2352 by 1568 pixels, 45-degree field of view, CFP:
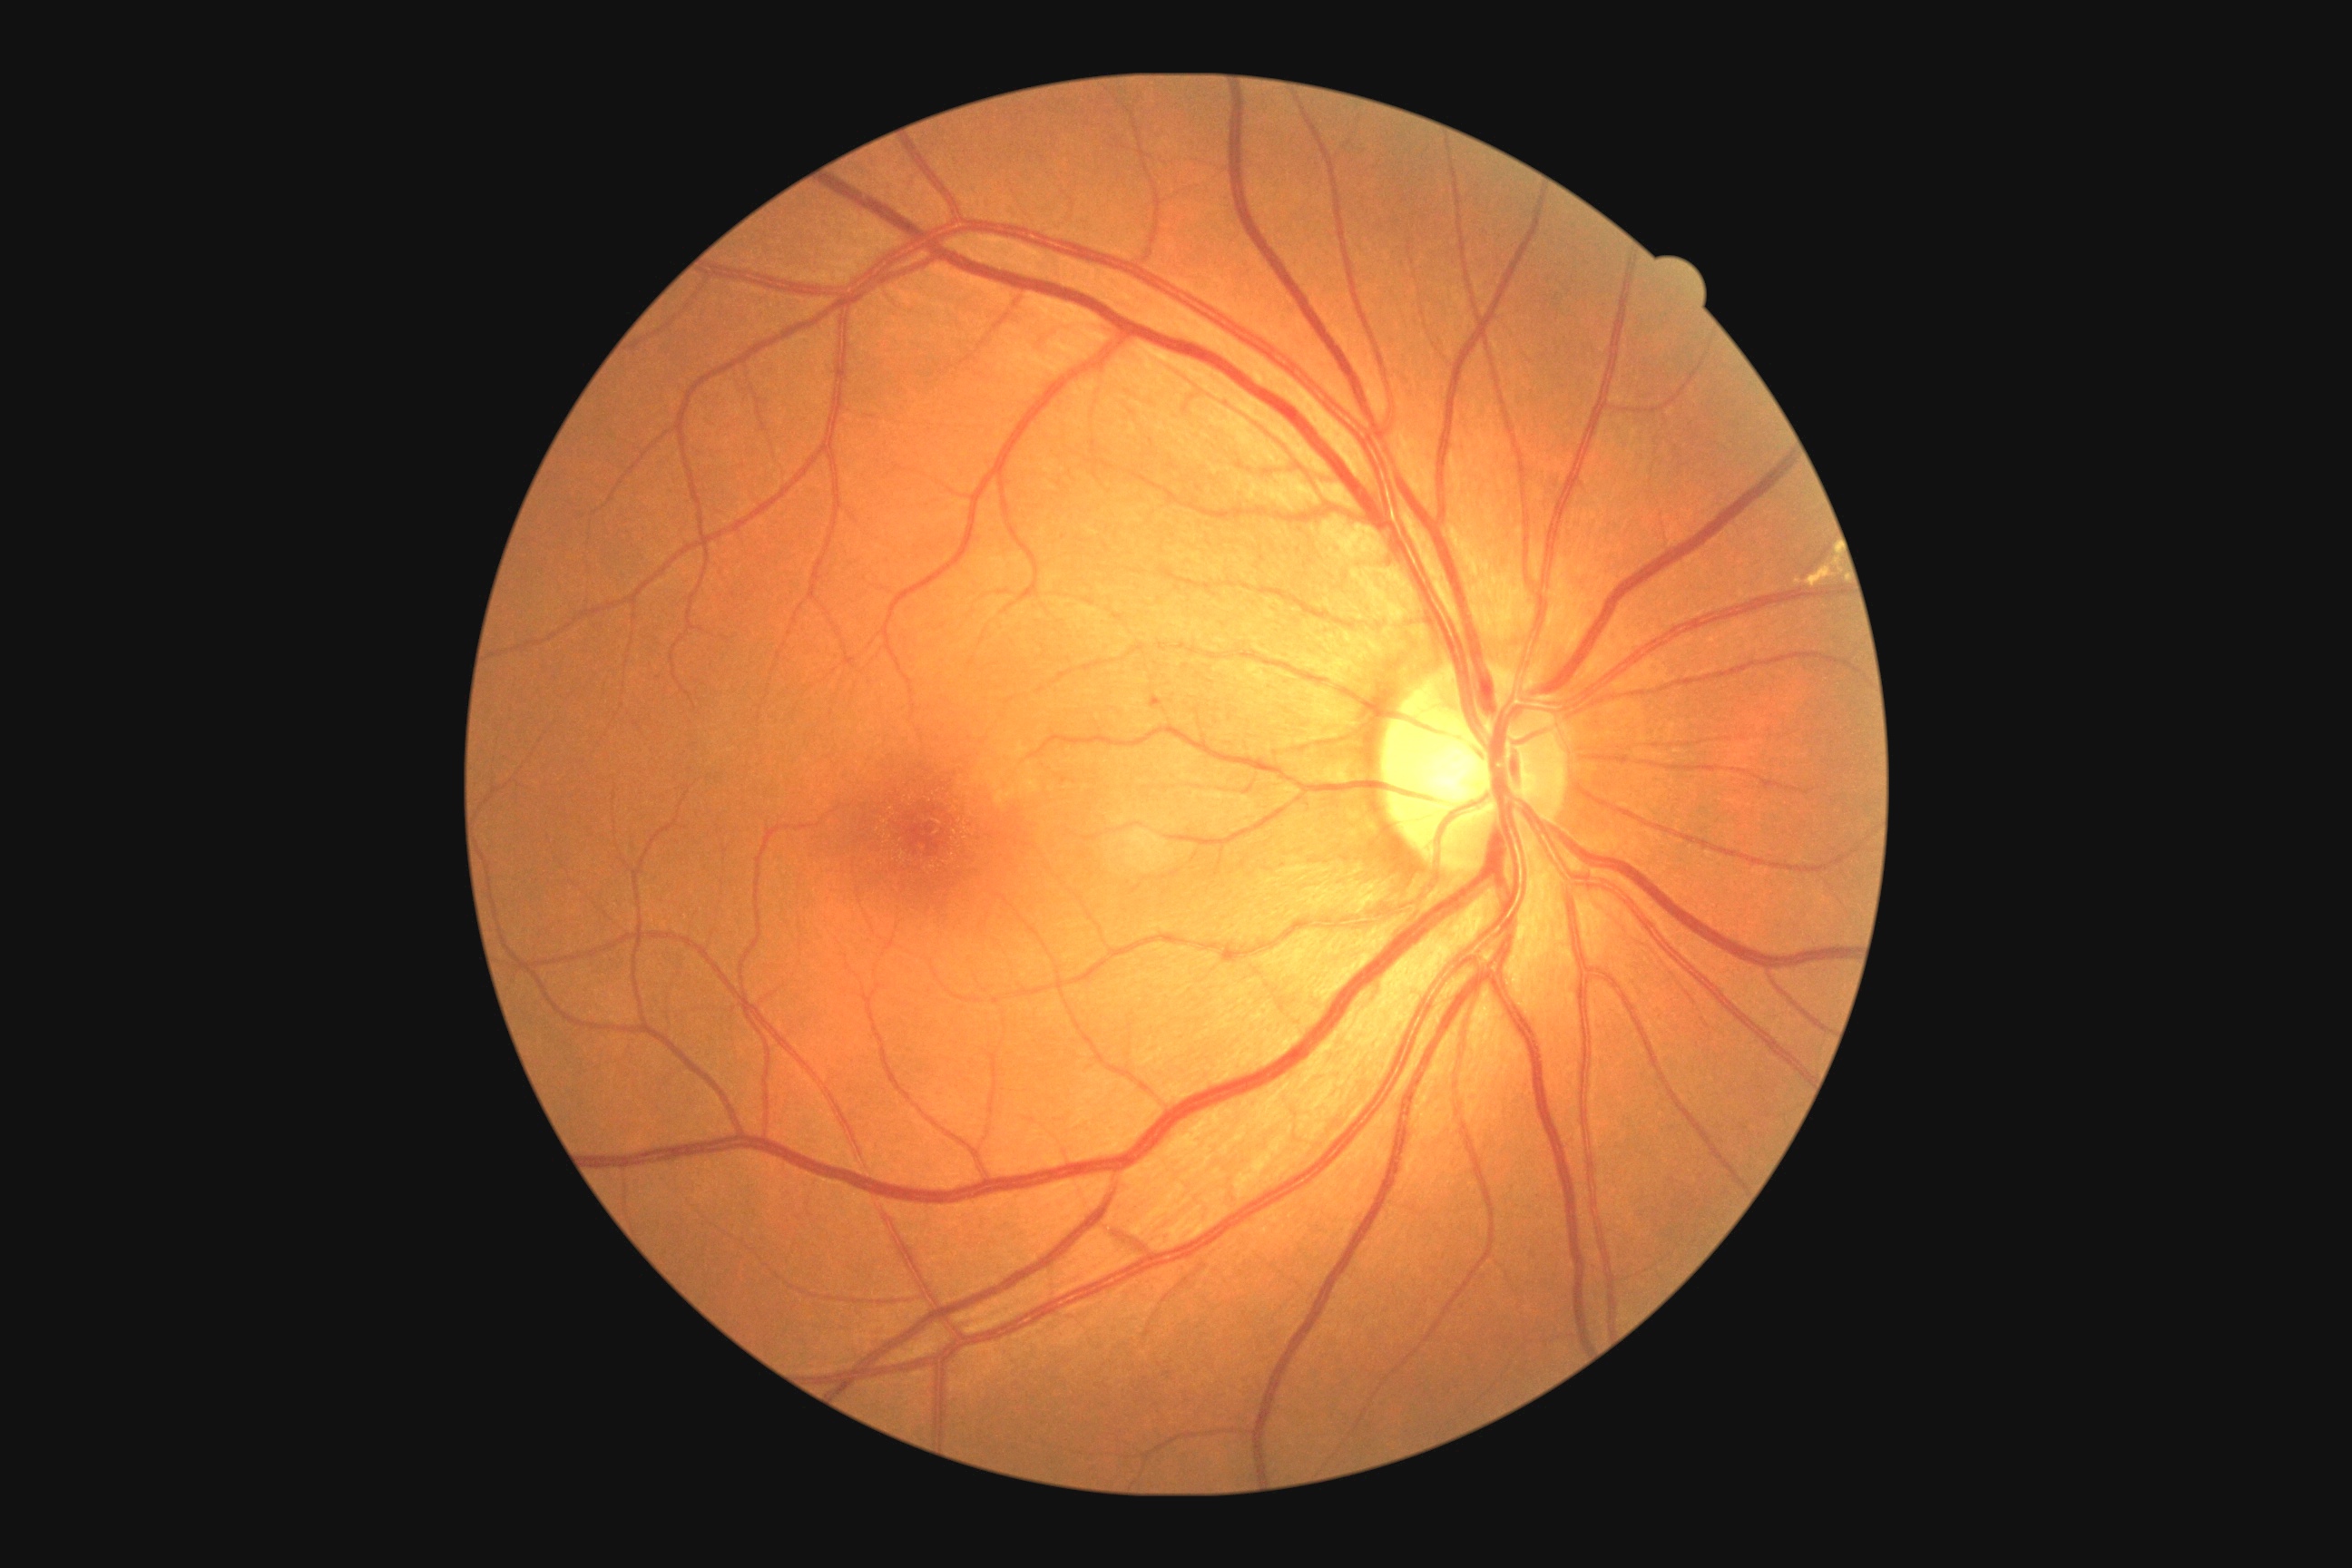
DR grade is 2/4. The retinopathy is classified as non-proliferative diabetic retinopathy.